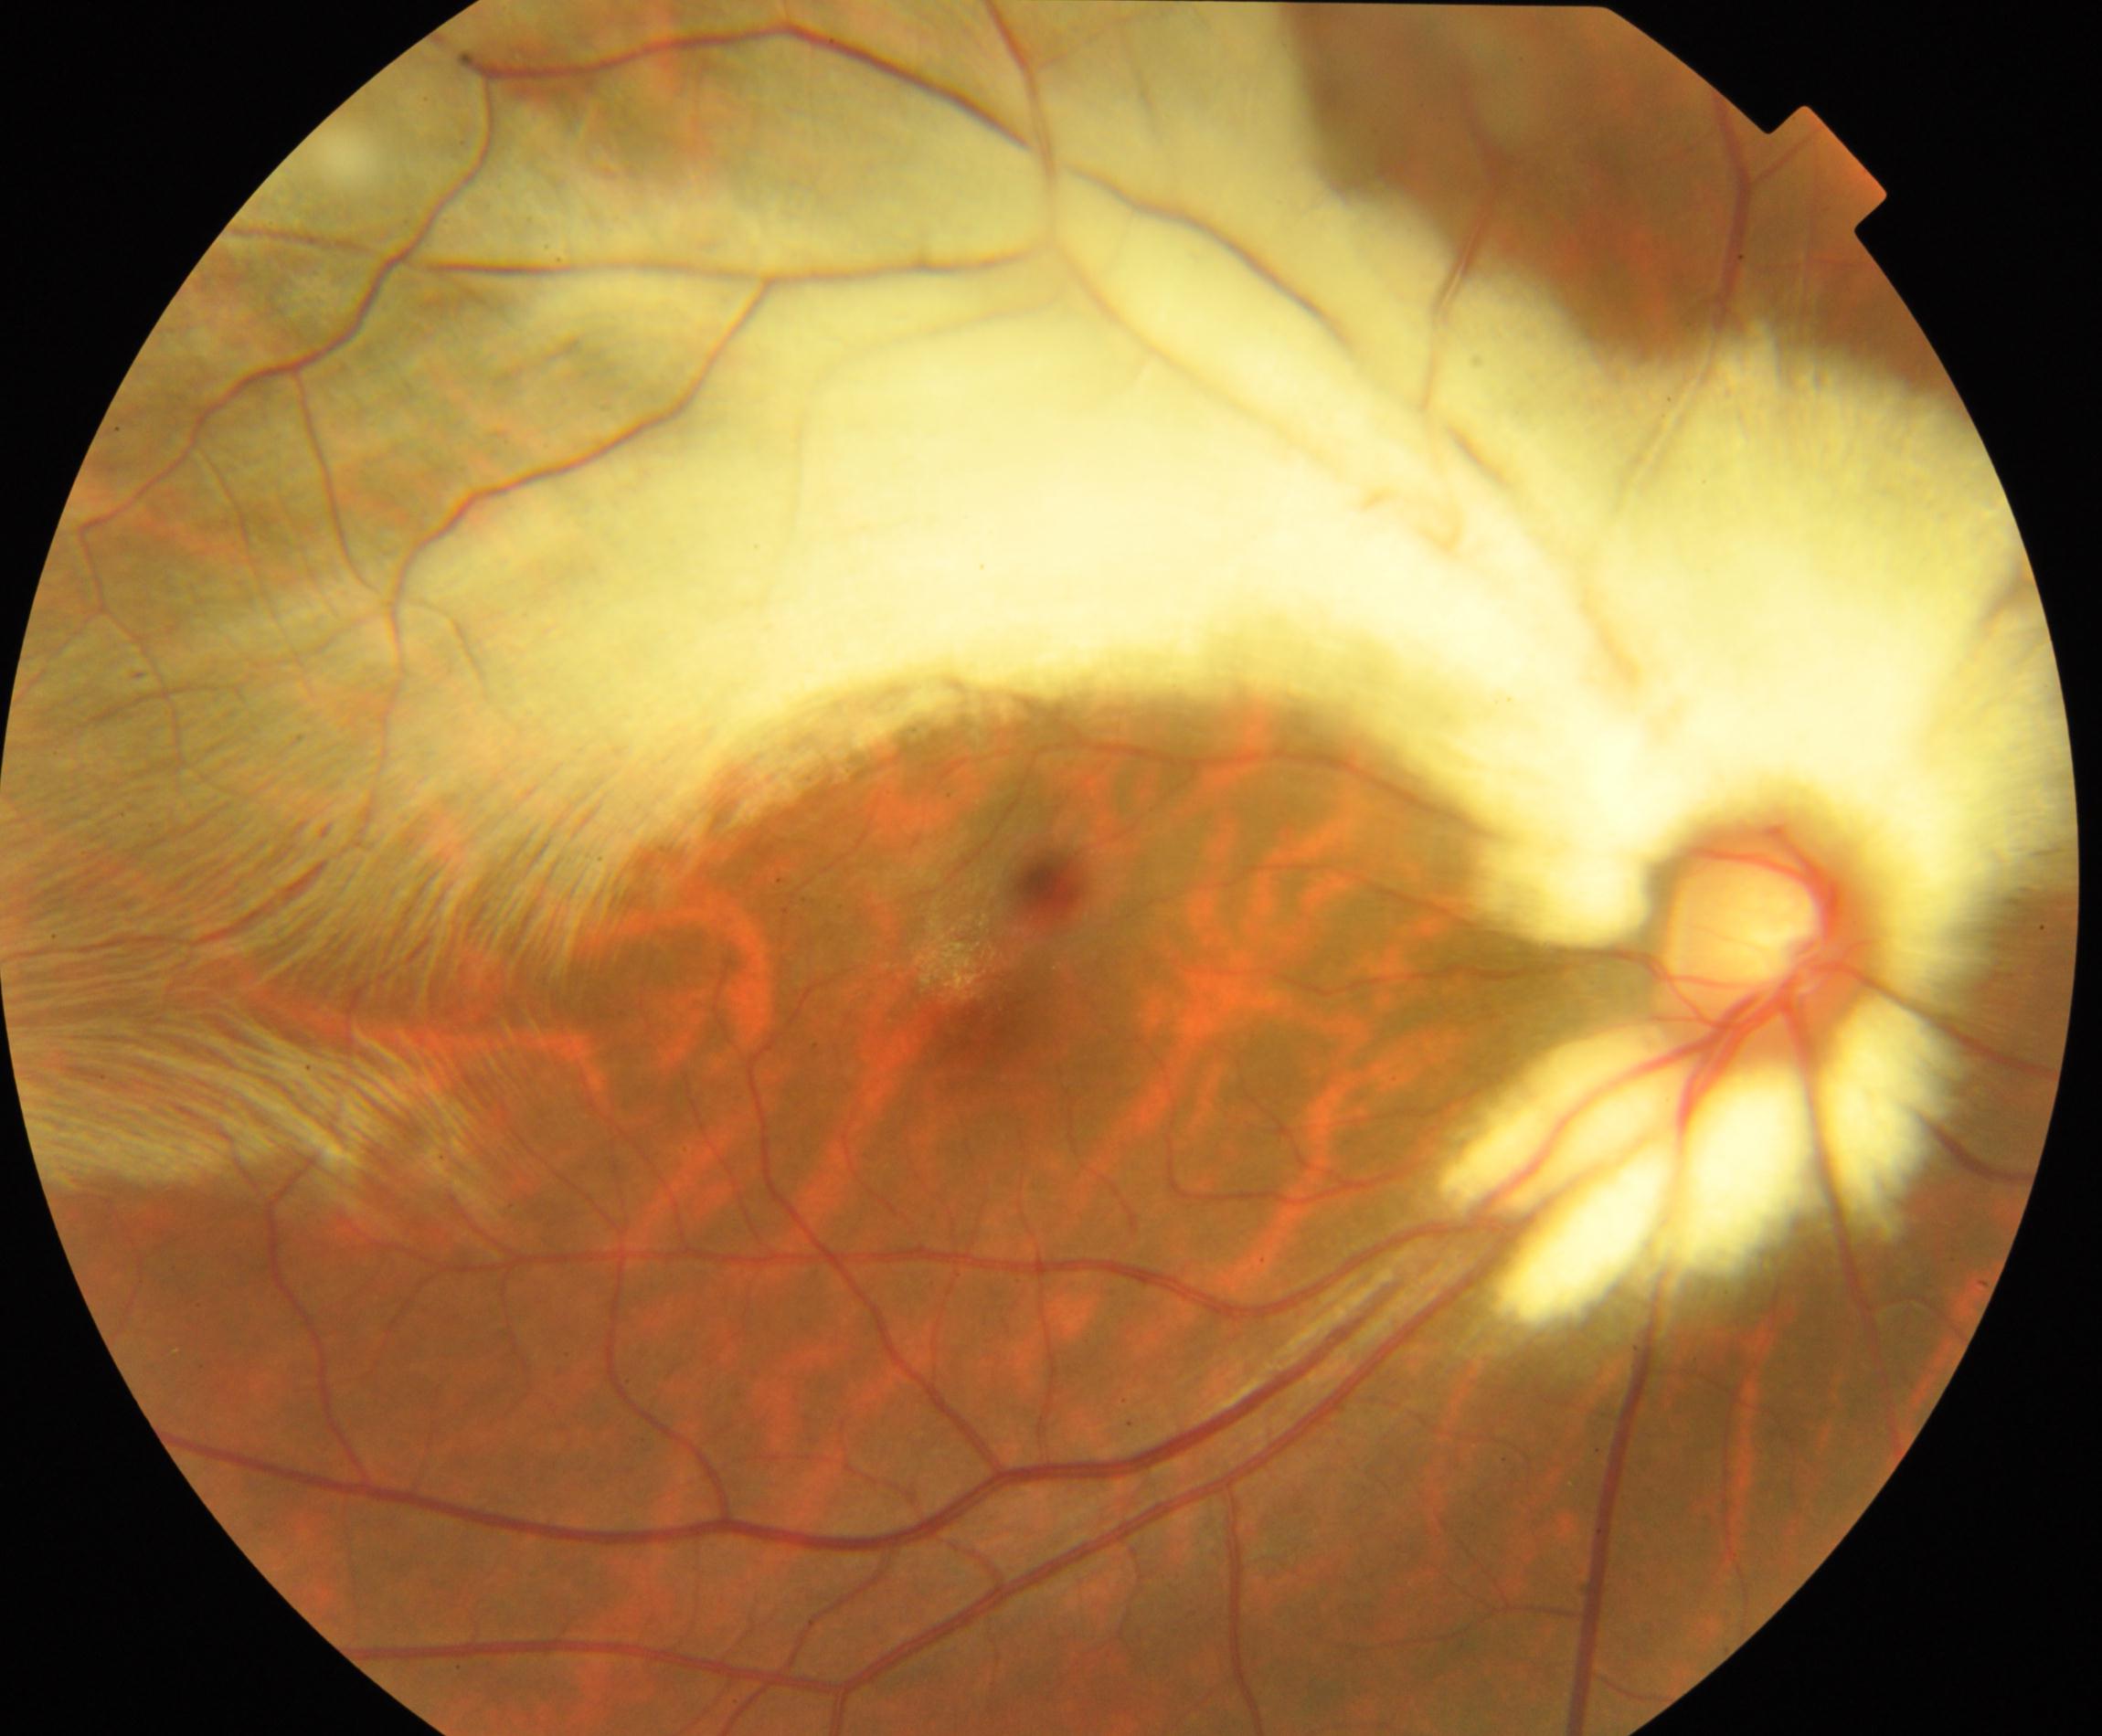

Primary finding: myelinated nerve fibers. Typically showing whitish striated patches with feathery borders that obscure retinal vessels.